45° FOV.
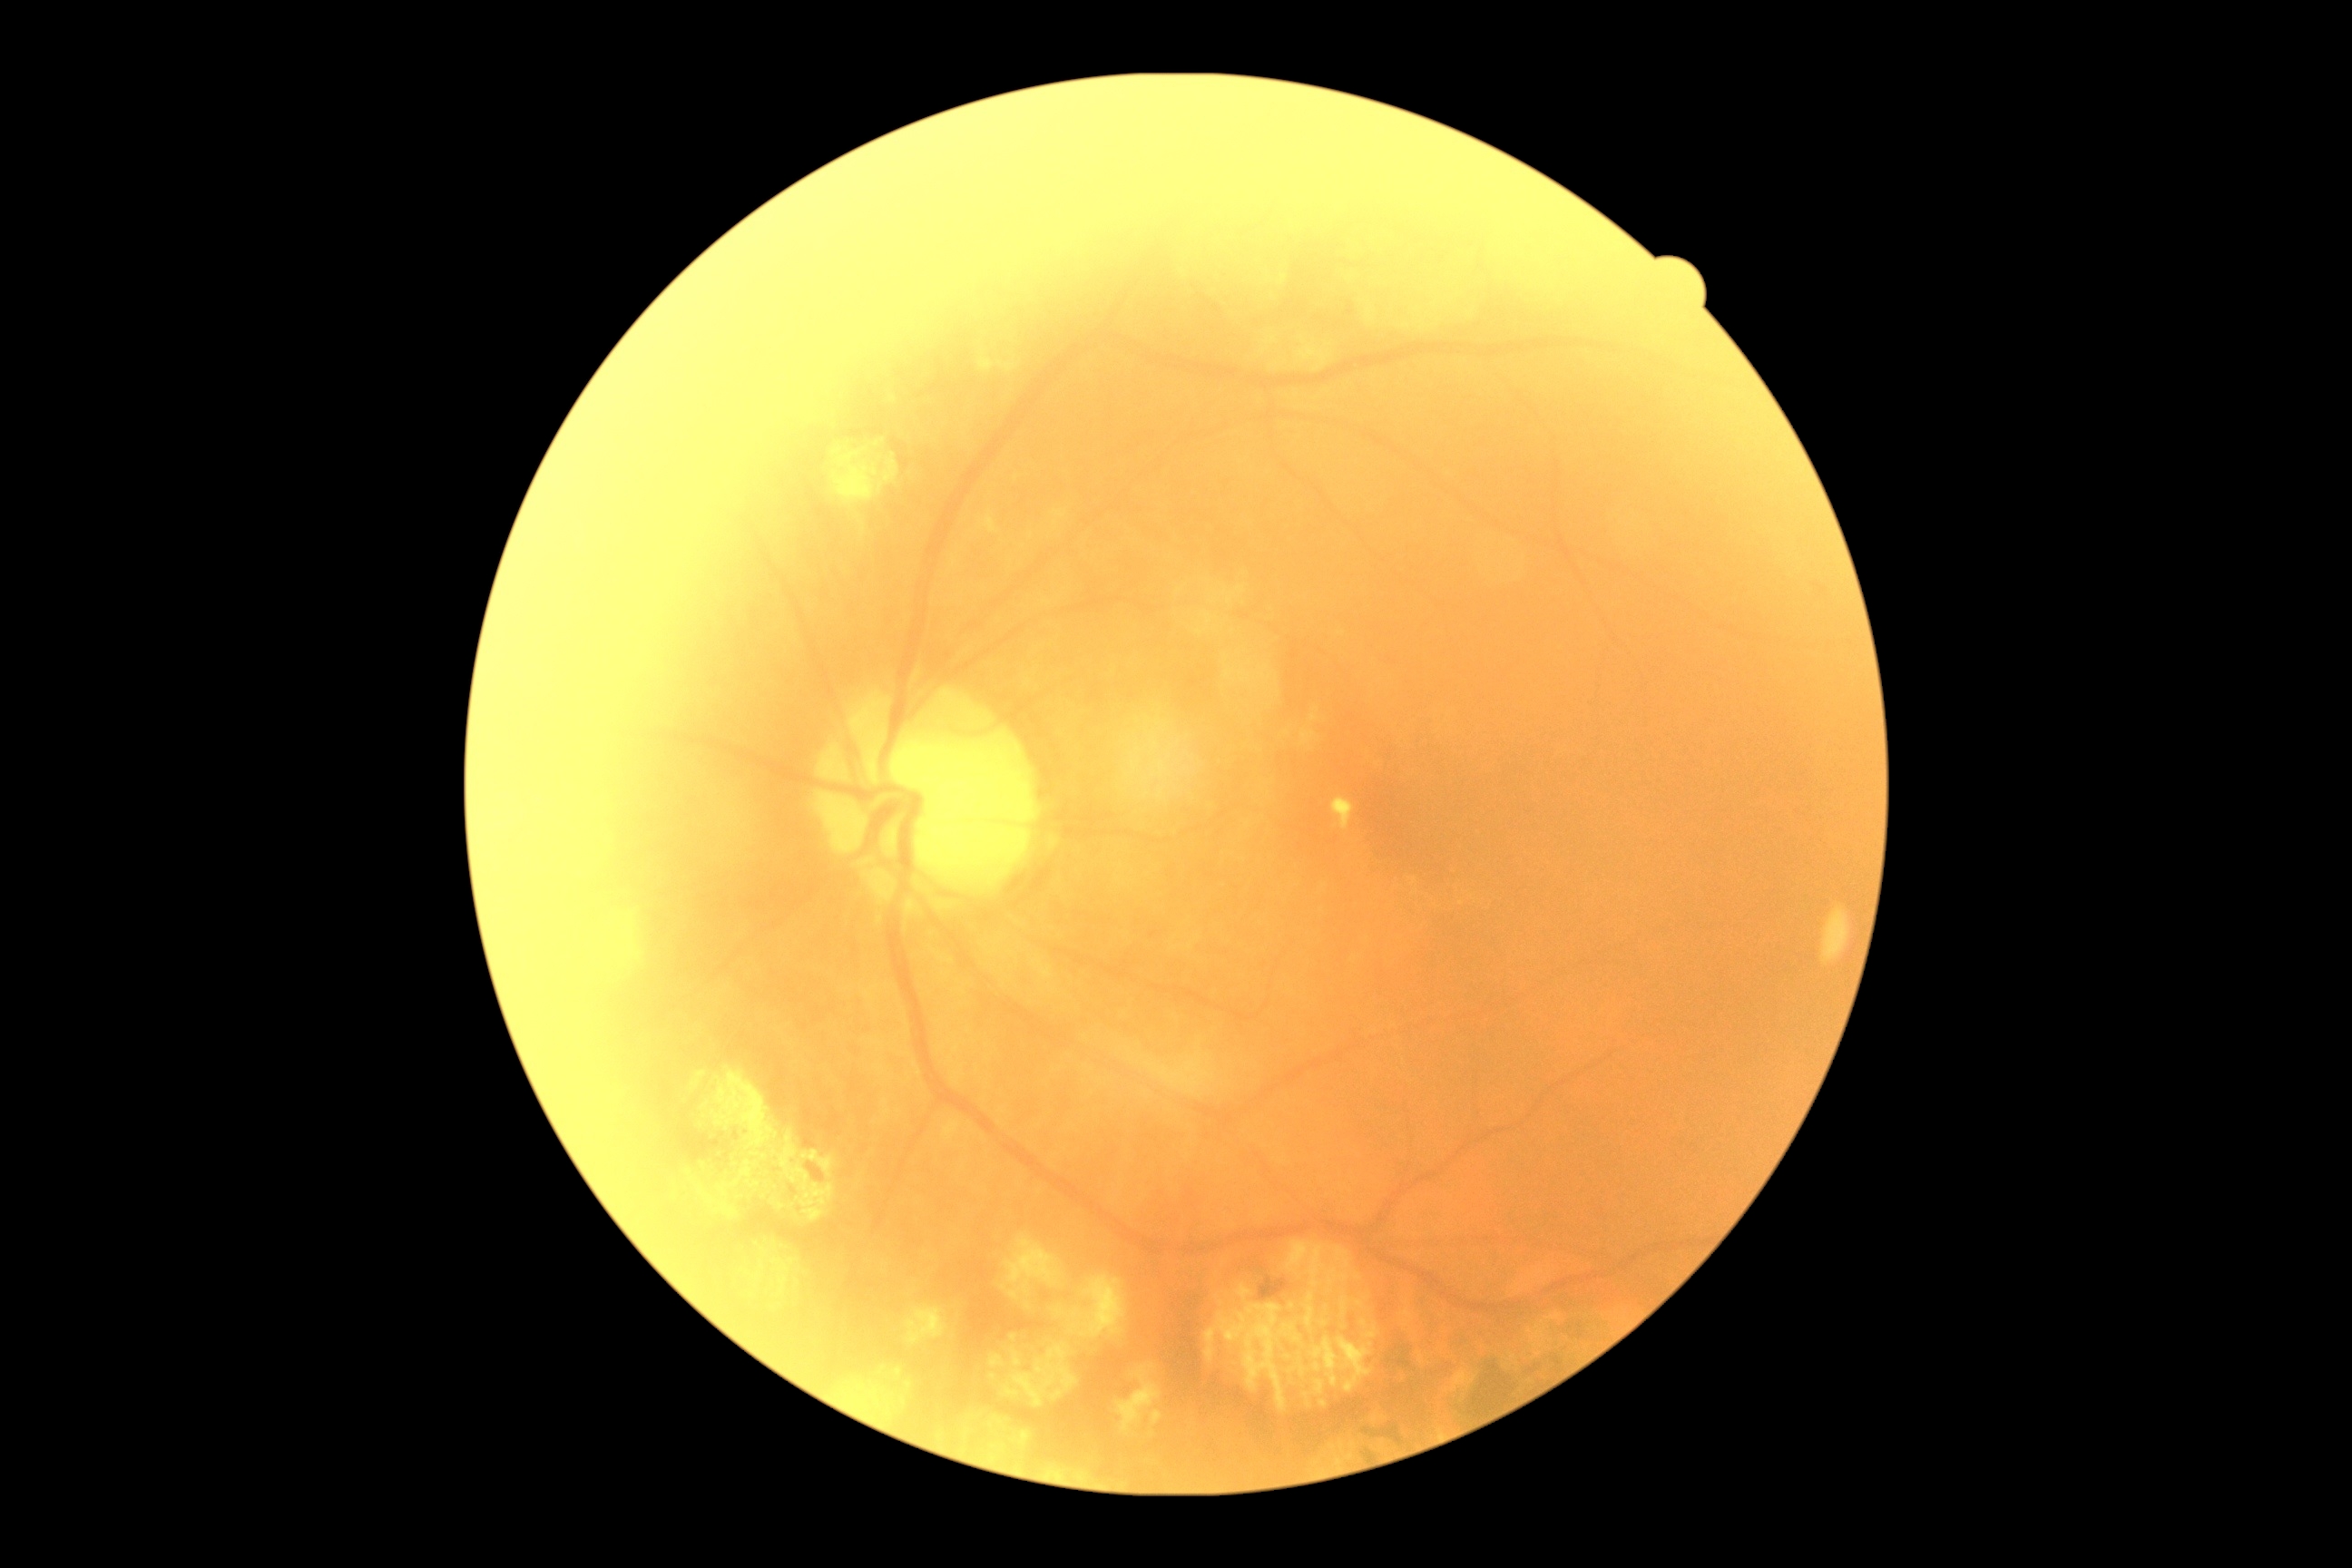 Diabetic retinopathy (DR): 2/4.